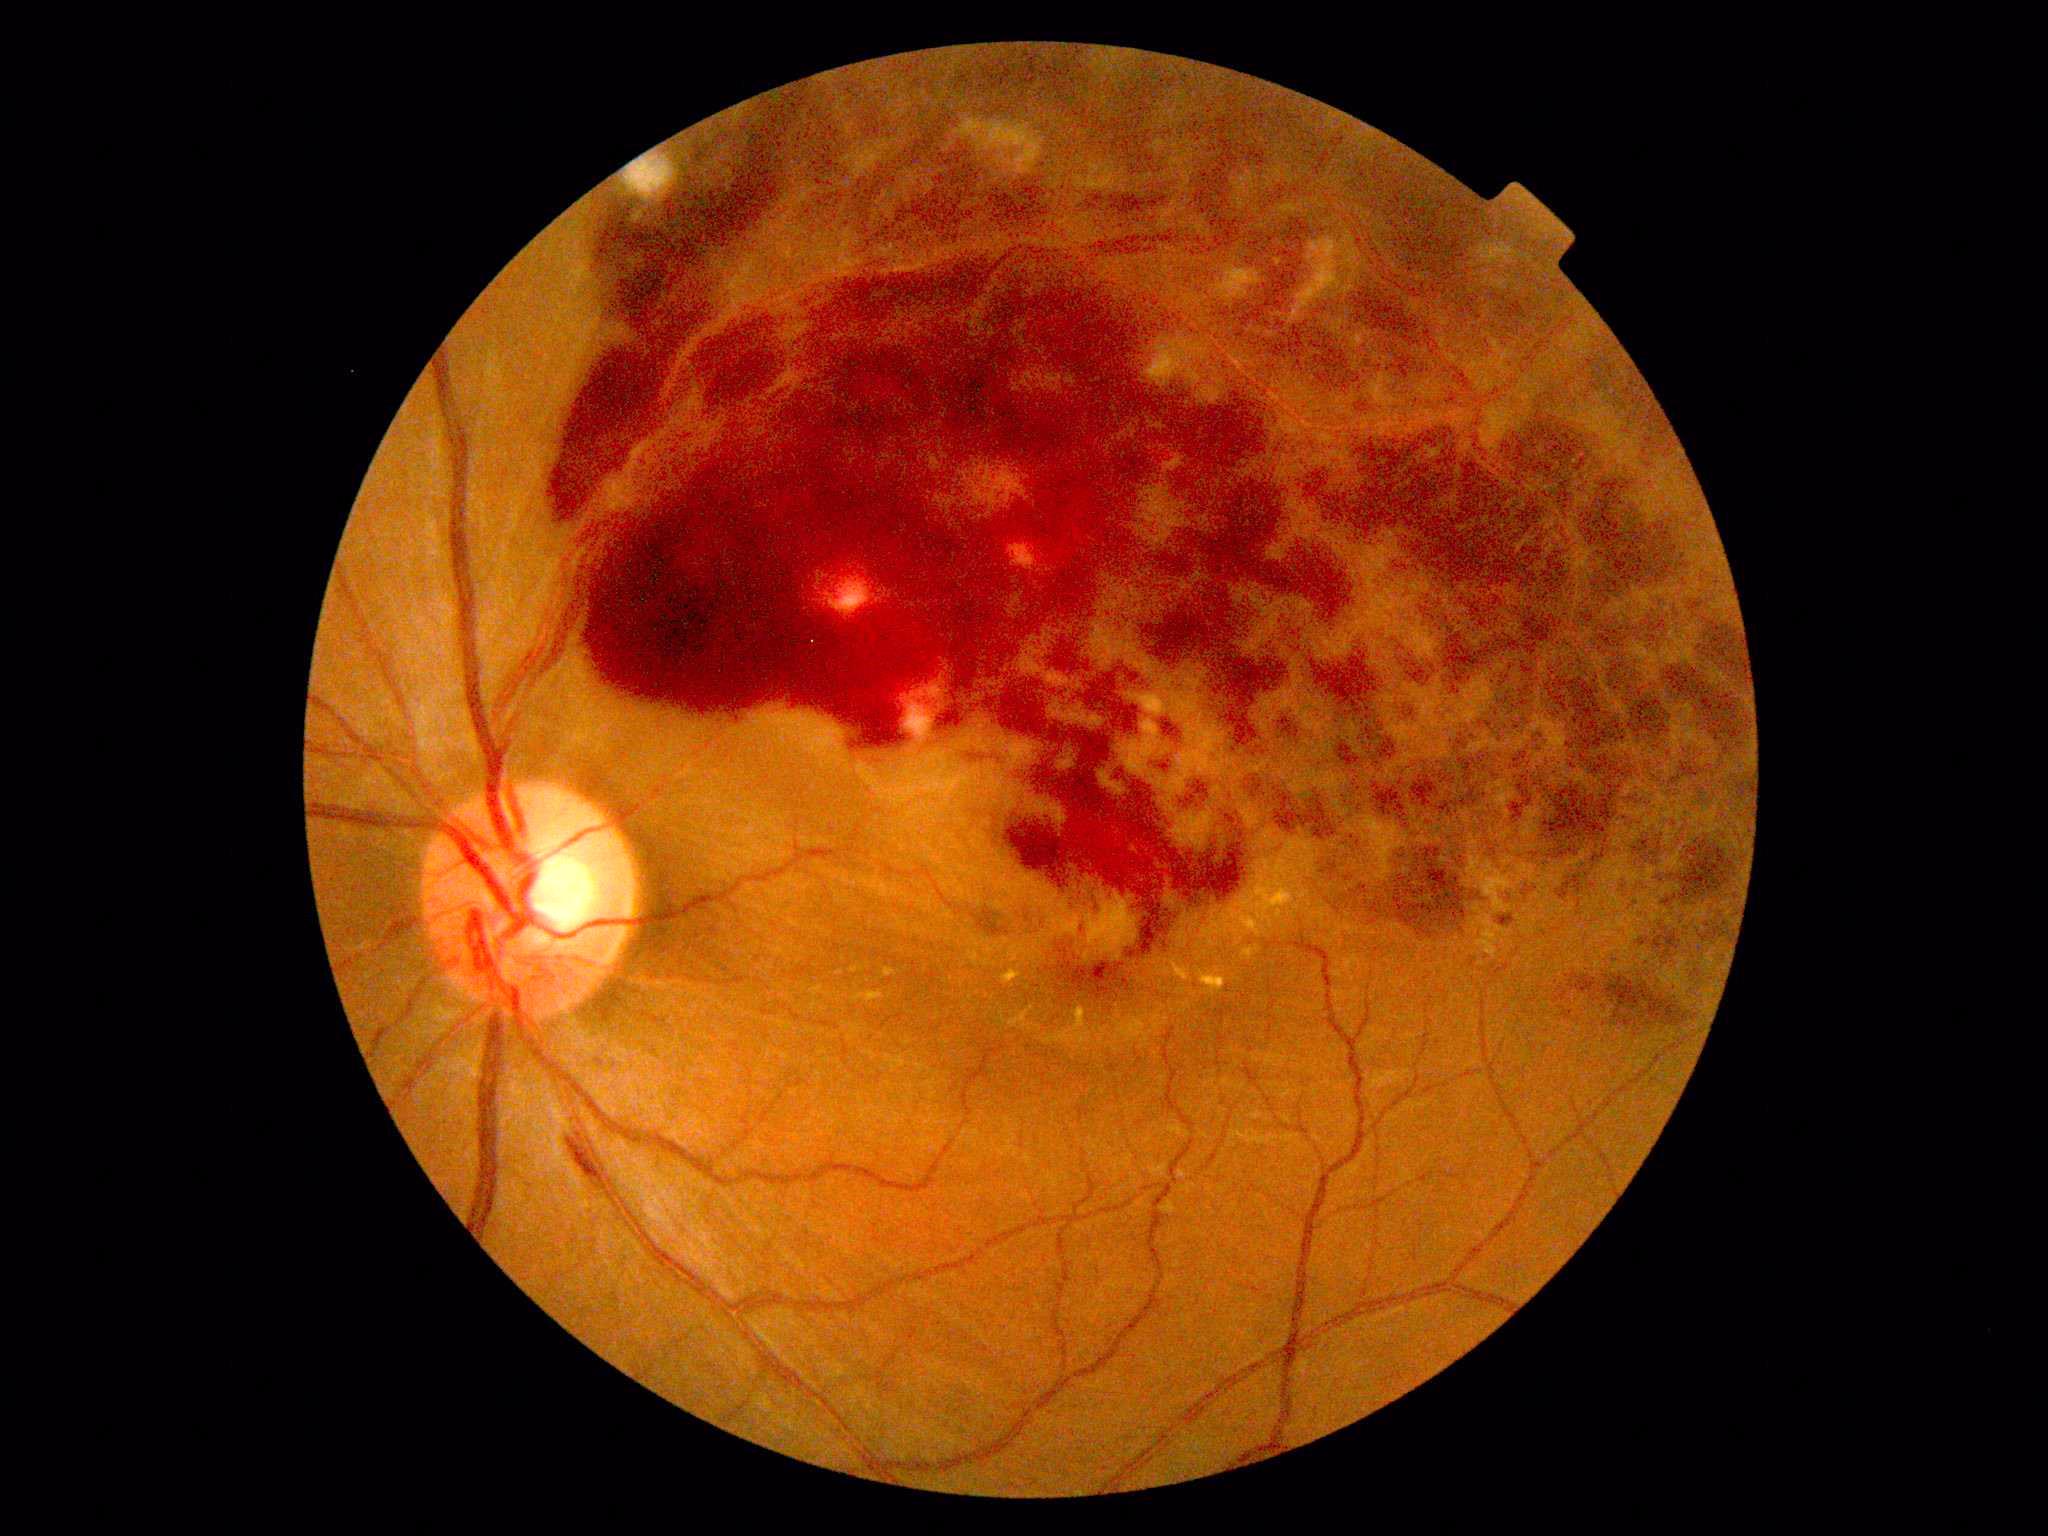
diabetic retinopathy (DR) = 4.